45 degree fundus photograph: 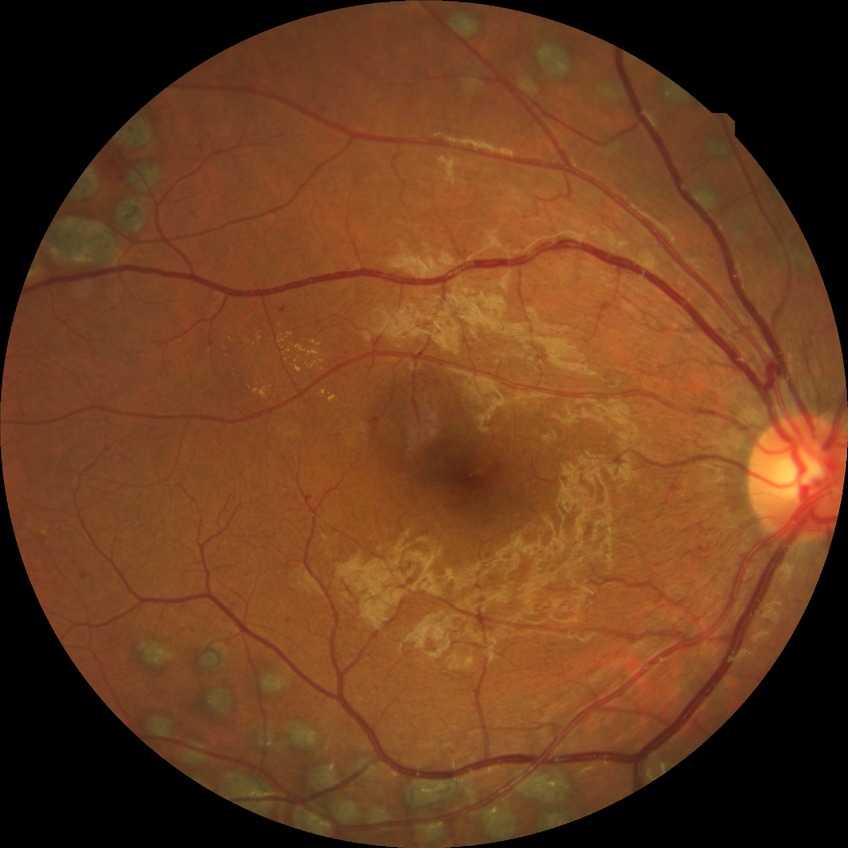
Annotations:
• diabetic retinopathy (DR): PDR (proliferative diabetic retinopathy)